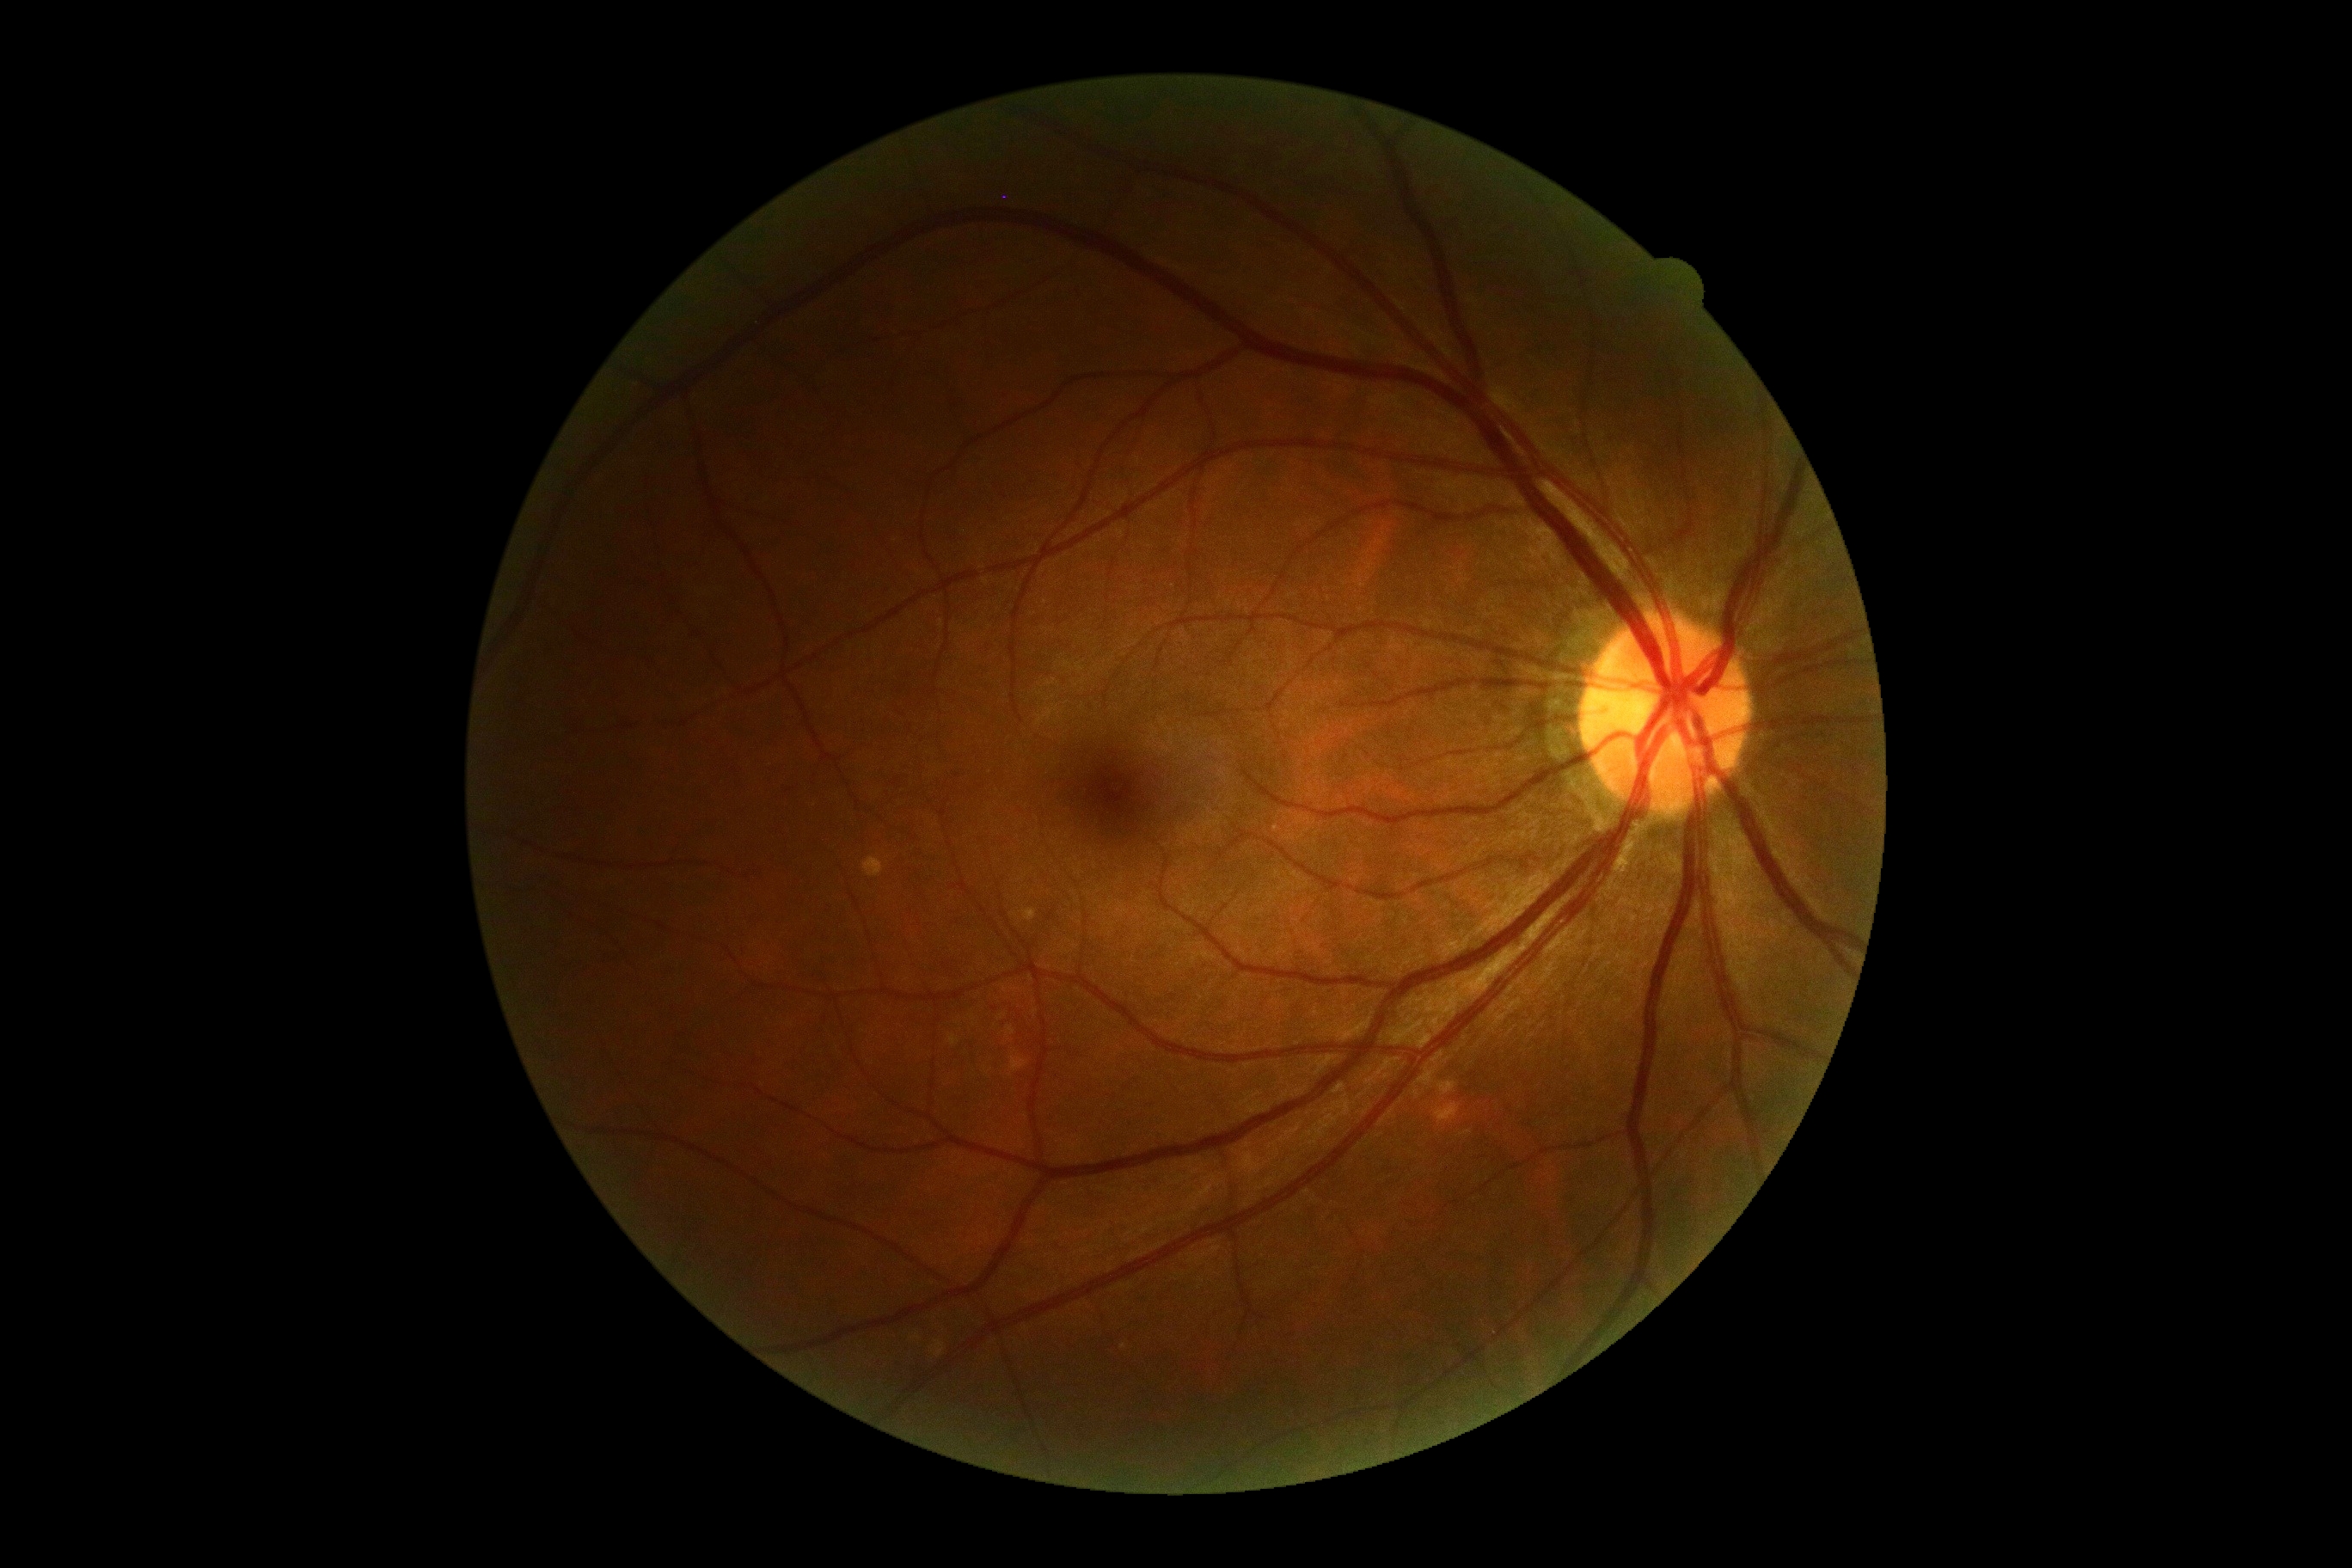 Annotations:
- diabetic retinopathy (DR): grade 0 — no visible signs of diabetic retinopathy